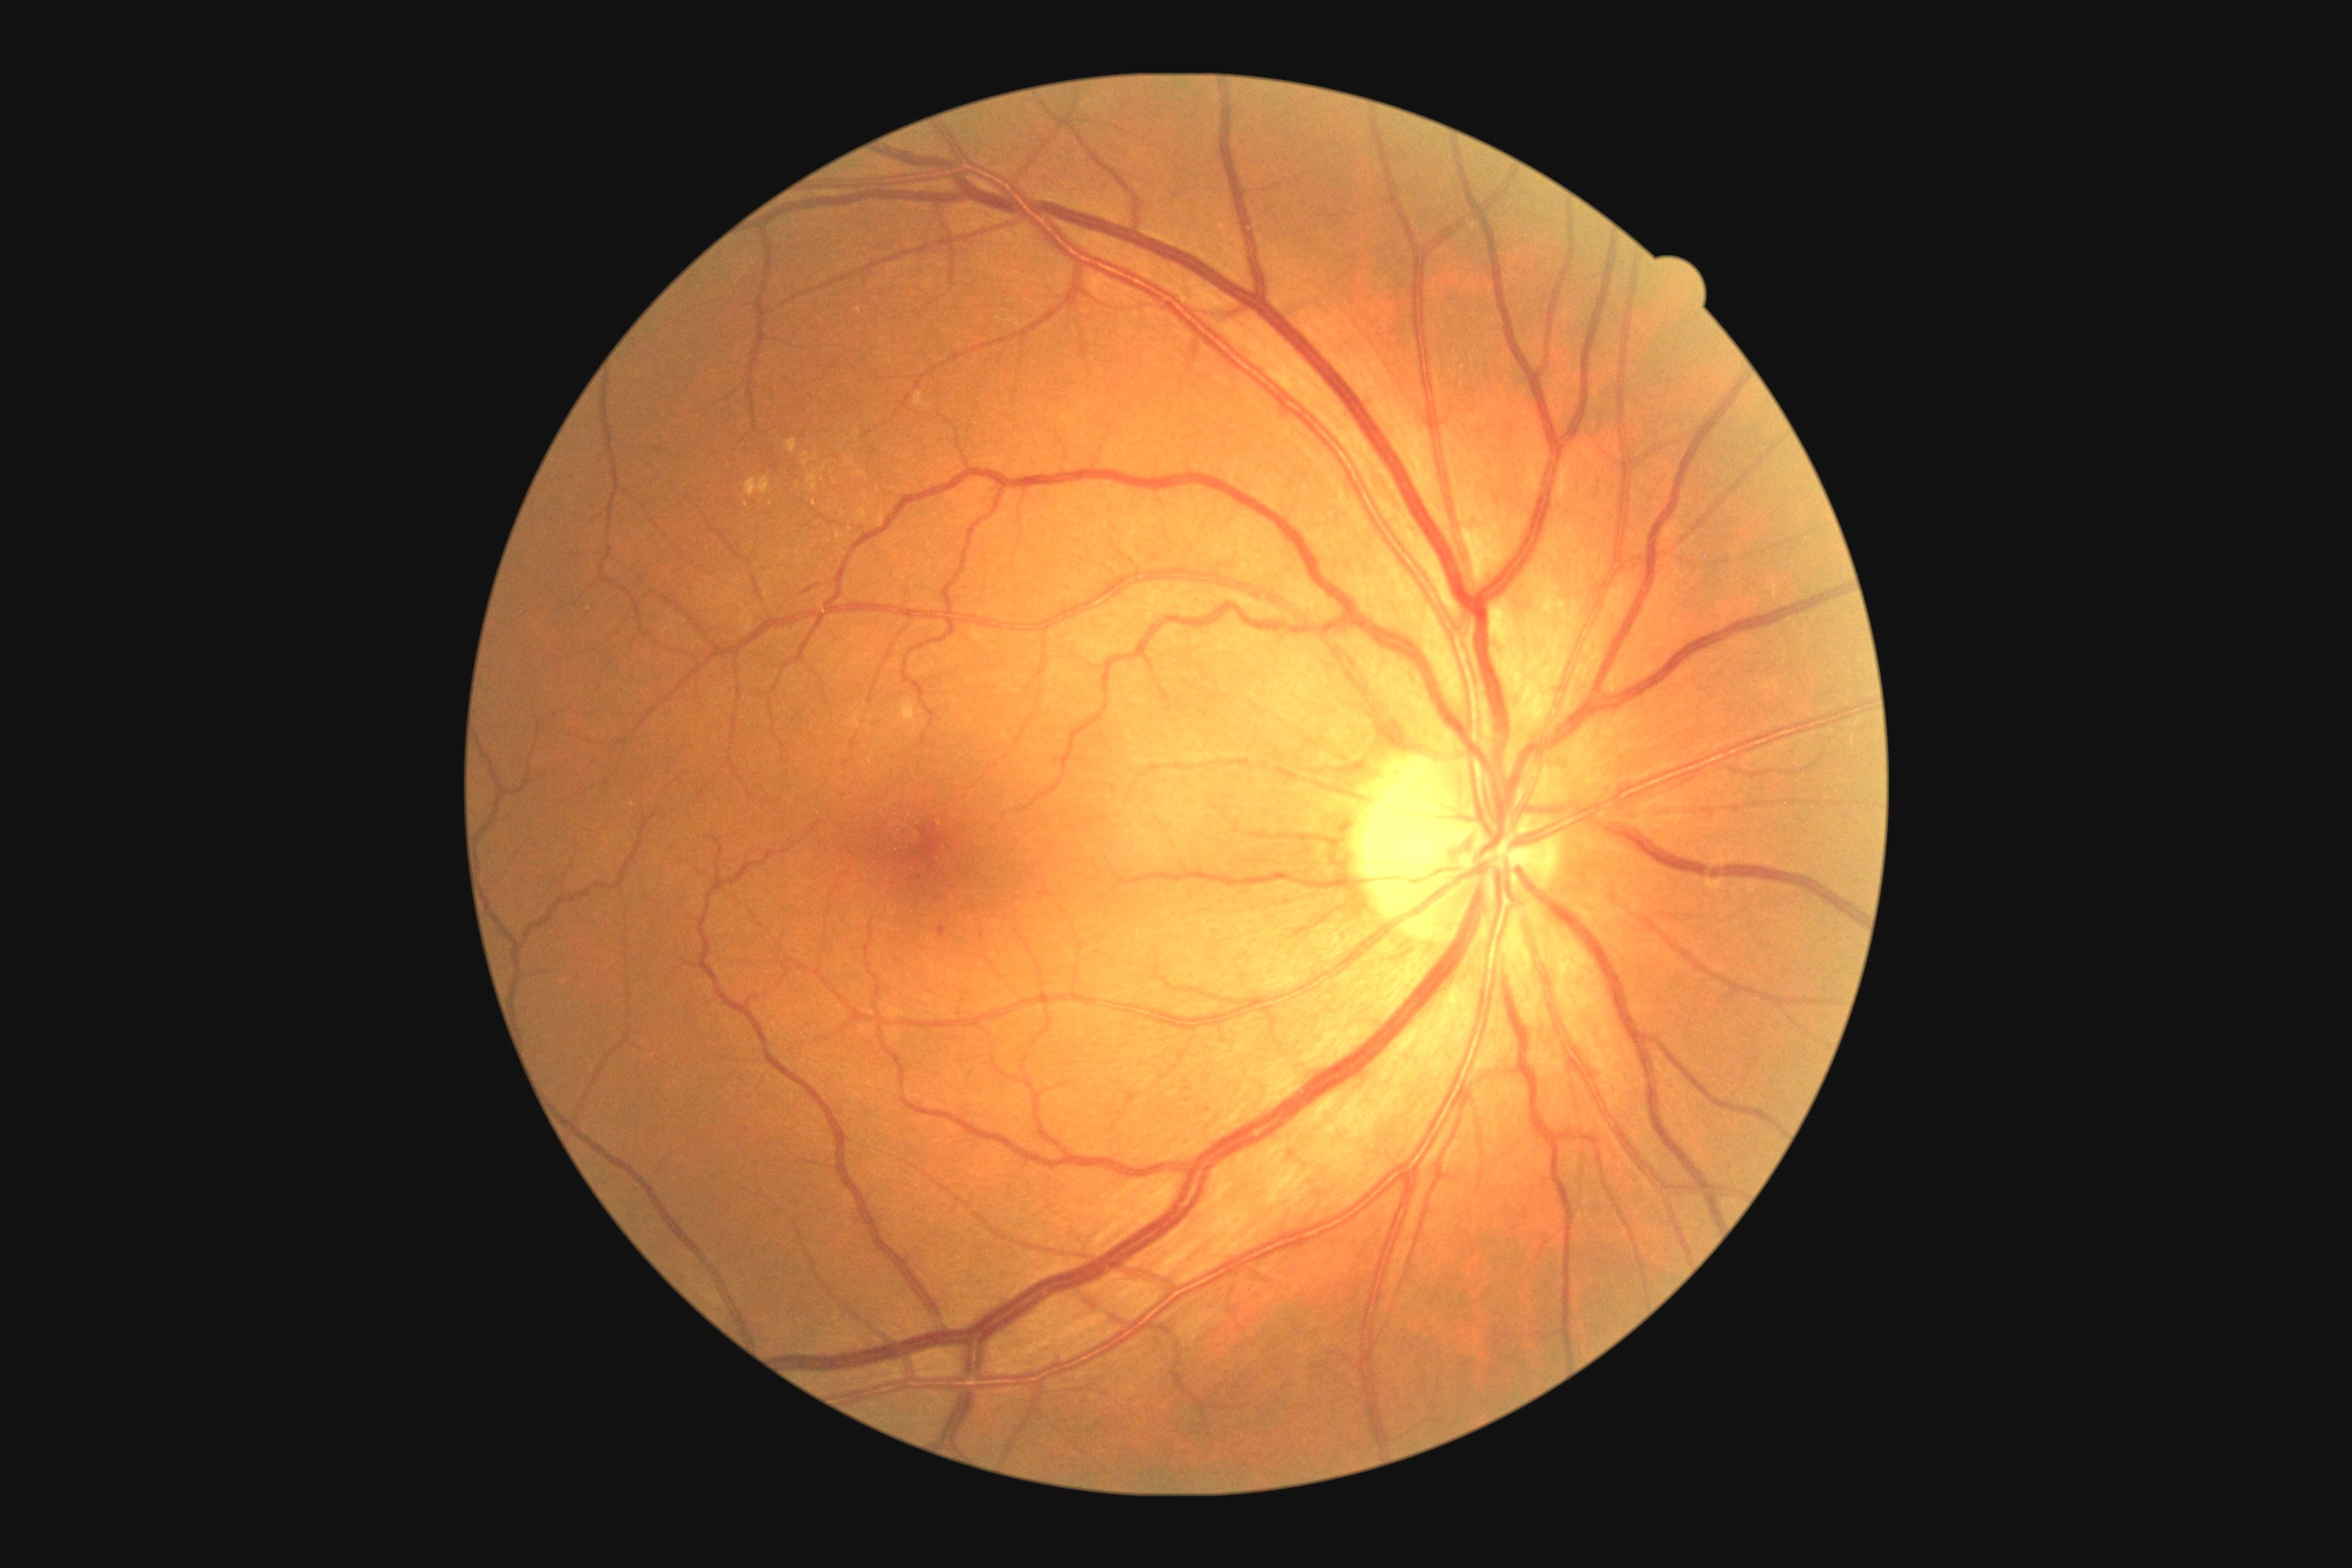 Retinopathy: mild non-proliferative diabetic retinopathy (grade 1); non-proliferative diabetic retinopathy. Microaneurysms present at {"left": 937, "top": 926, "right": 948, "bottom": 937}. Smaller microaneurysms around 919, 878. No hard exudates identified. No soft exudates identified. No hemorrhages identified.